Man; refraction: -2.5 -2.25 x 5; intraocular pressure by non-contact tonometry: 16 mmHg; central corneal thickness: 529 µm; fundus photo; axial length (AL): 24.31 mm:
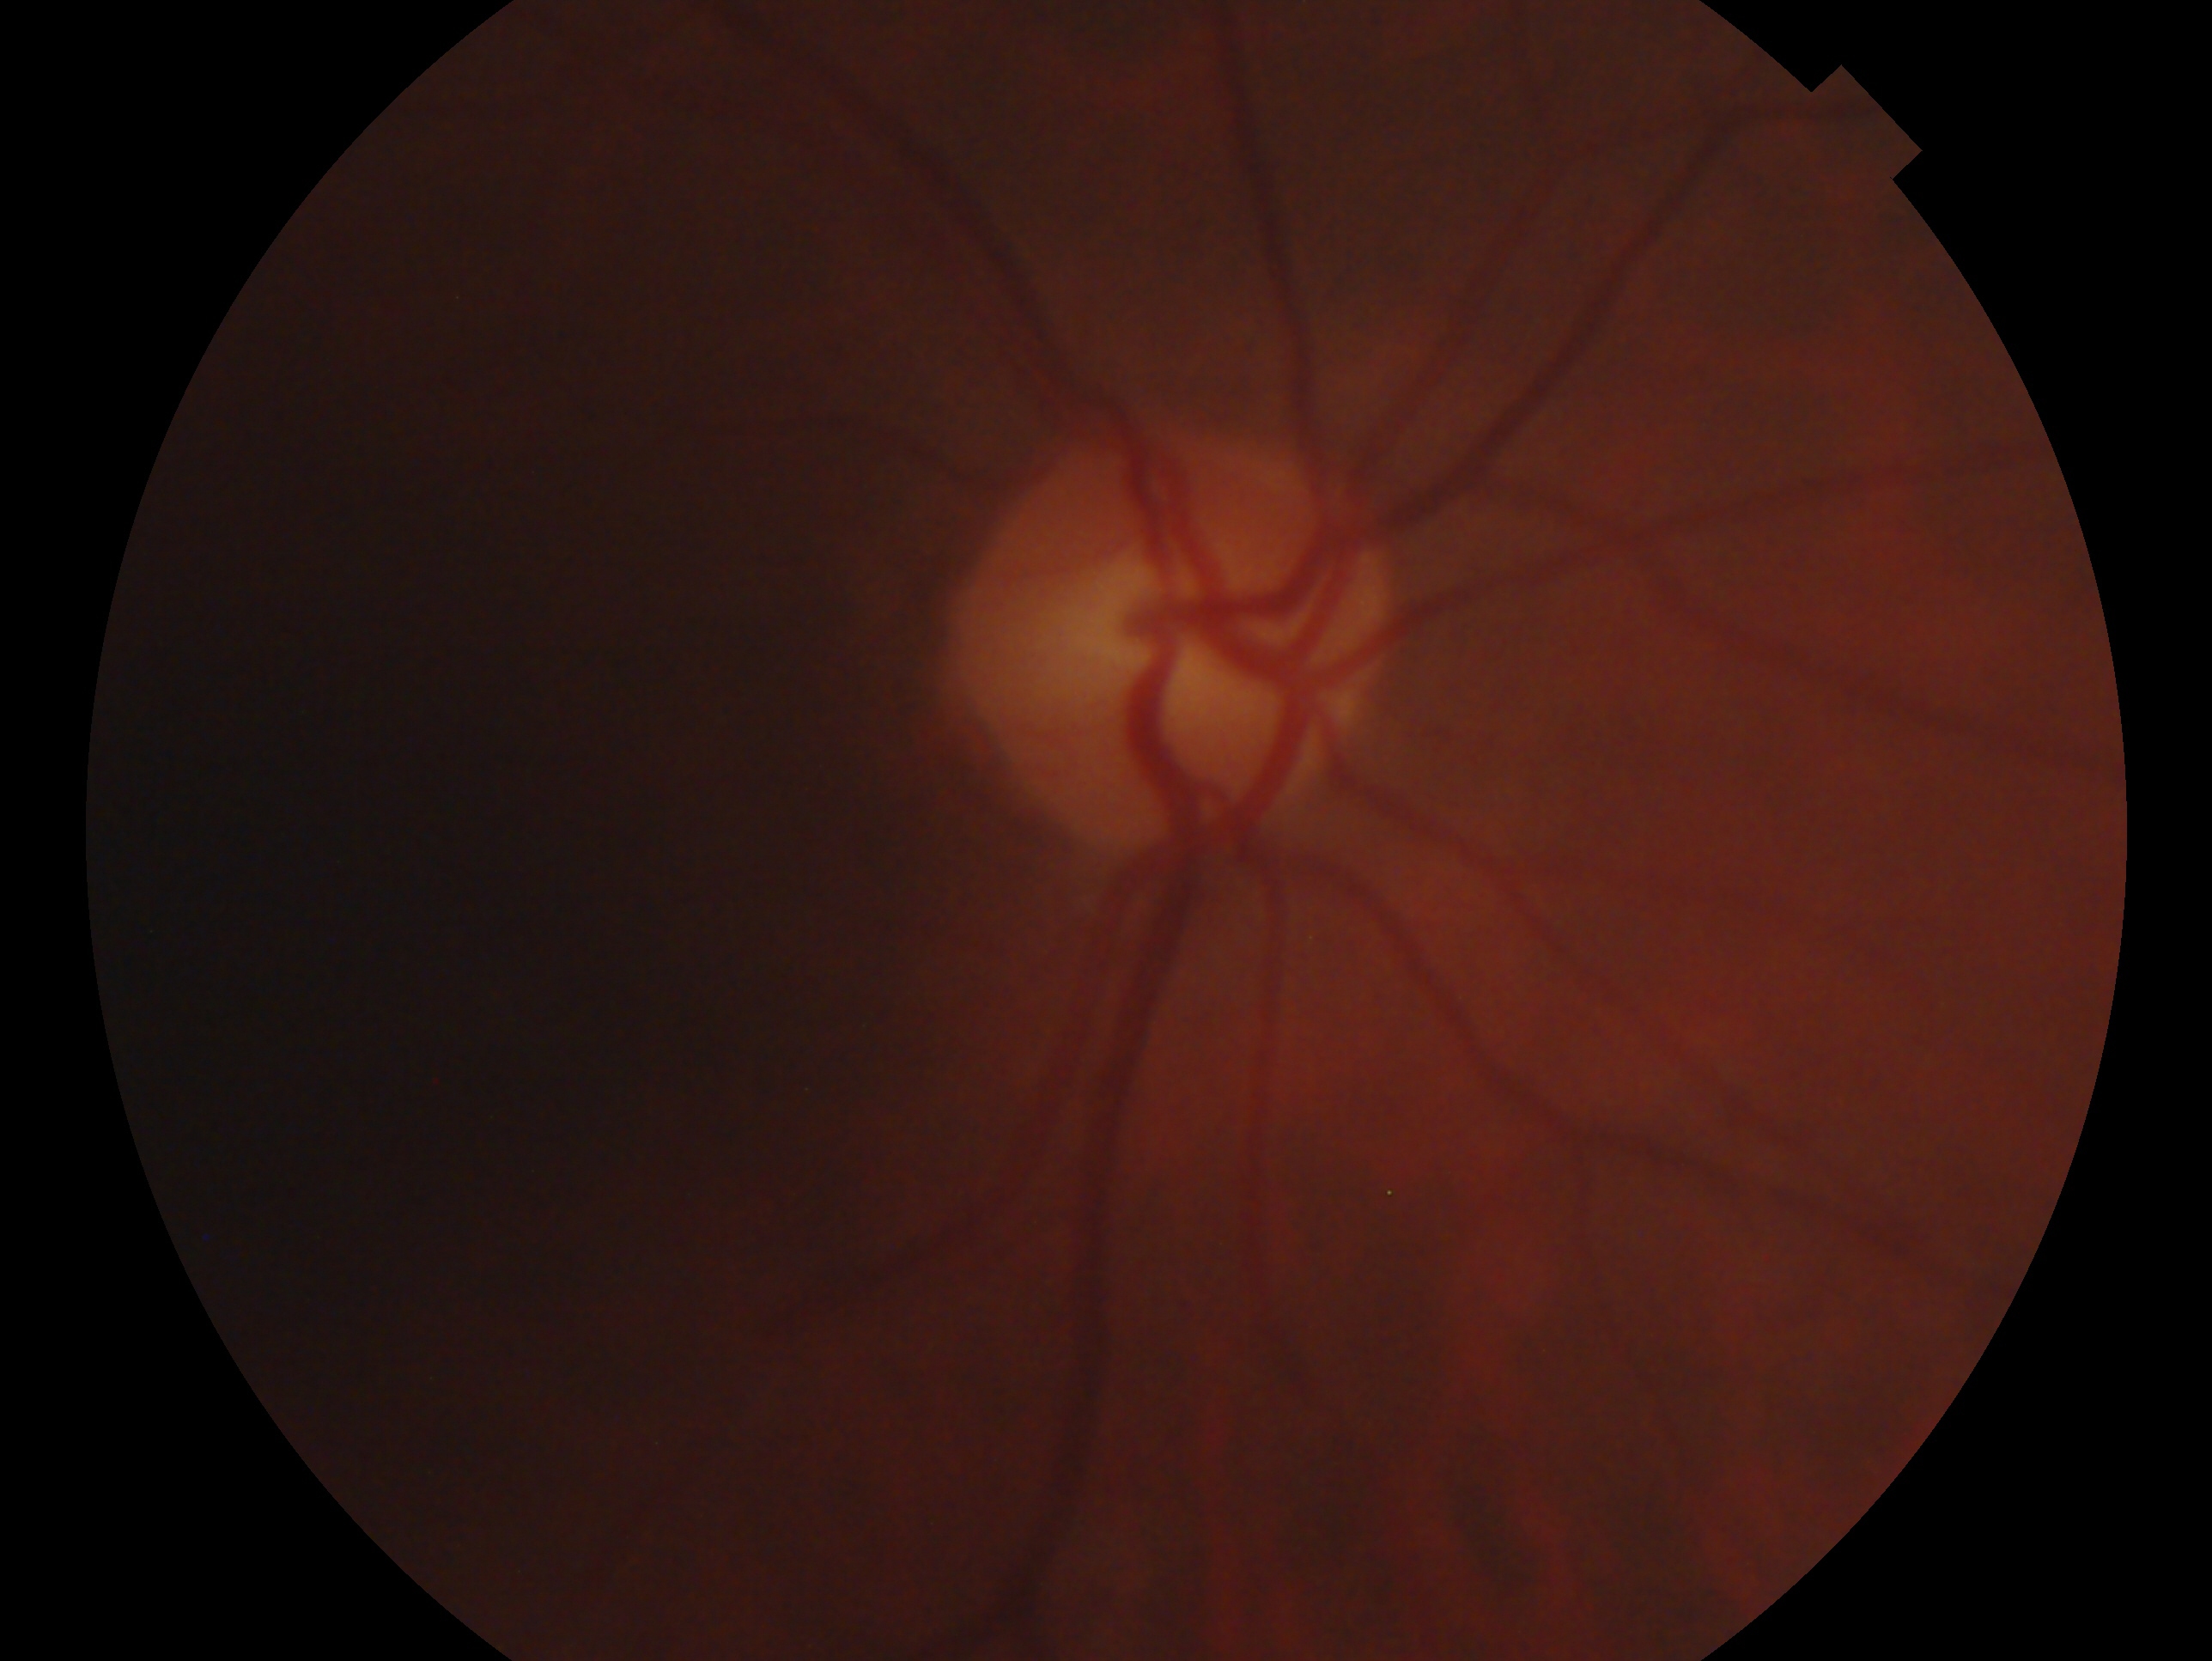

Imaged eye: oculus dexter. Diagnosis — no evidence of glaucoma.